Color fundus image.
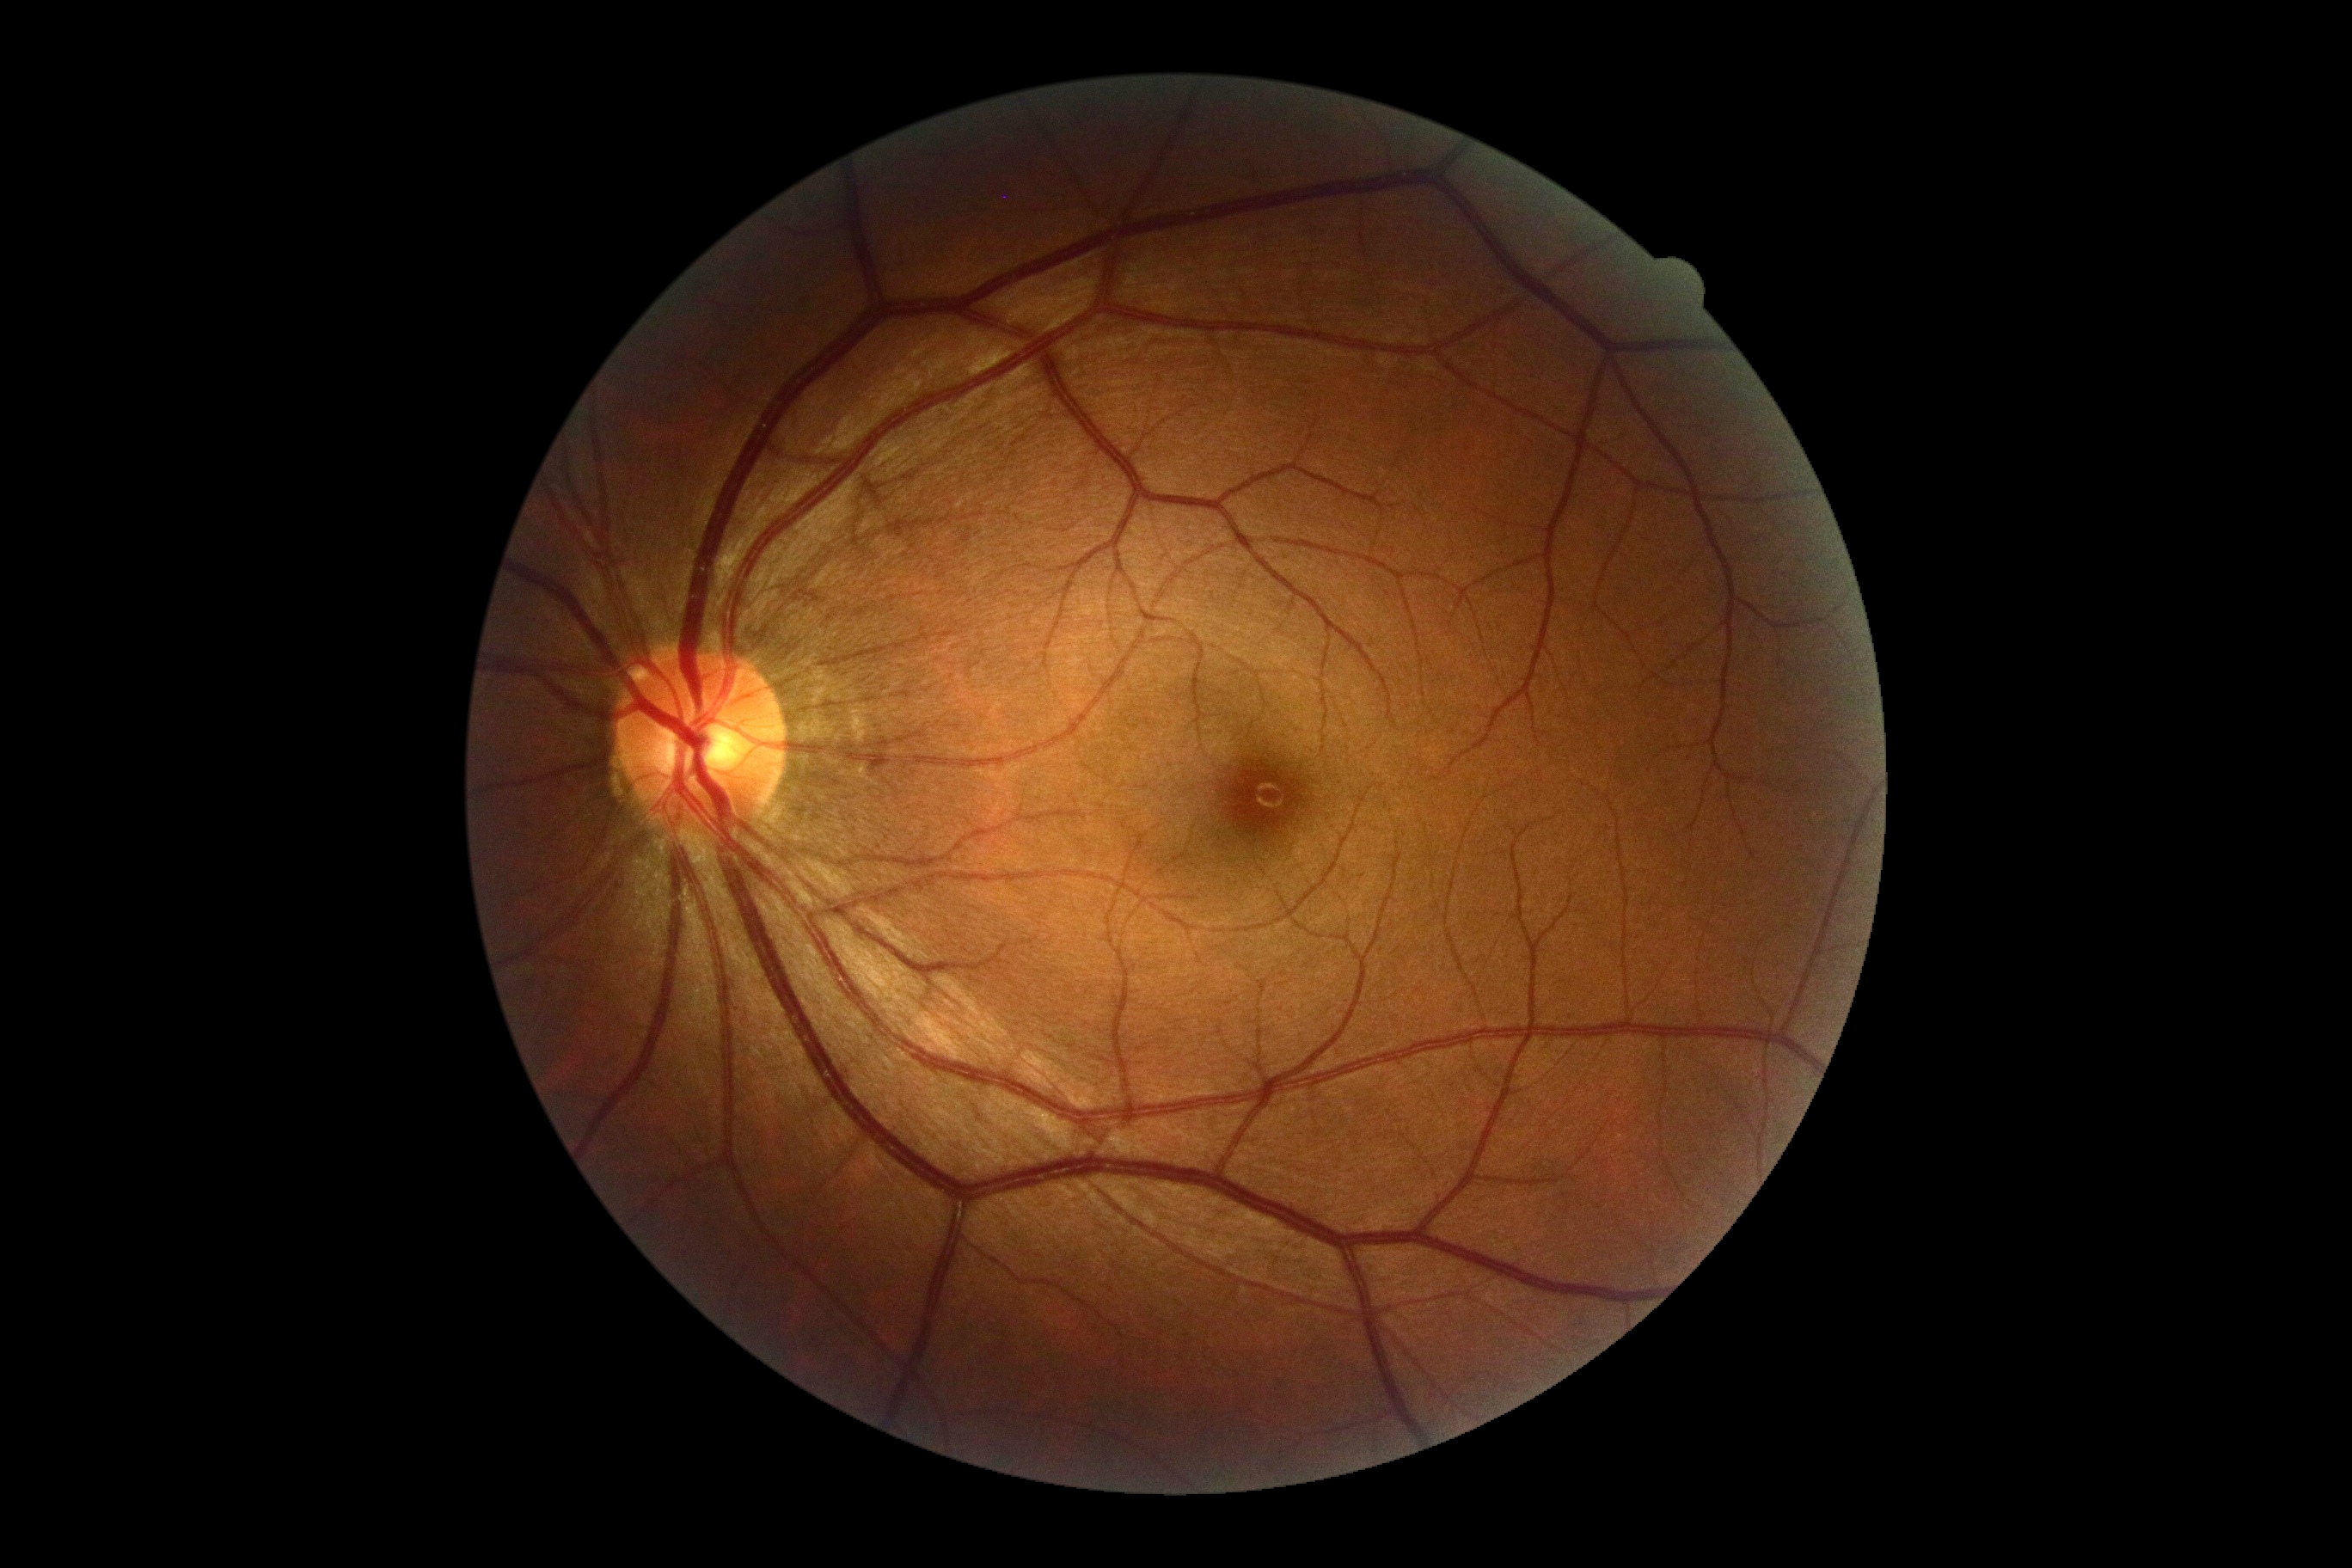 DR severity is grade 0.